Wide-field contact fundus photograph of an infant; 100° field of view (Phoenix ICON)
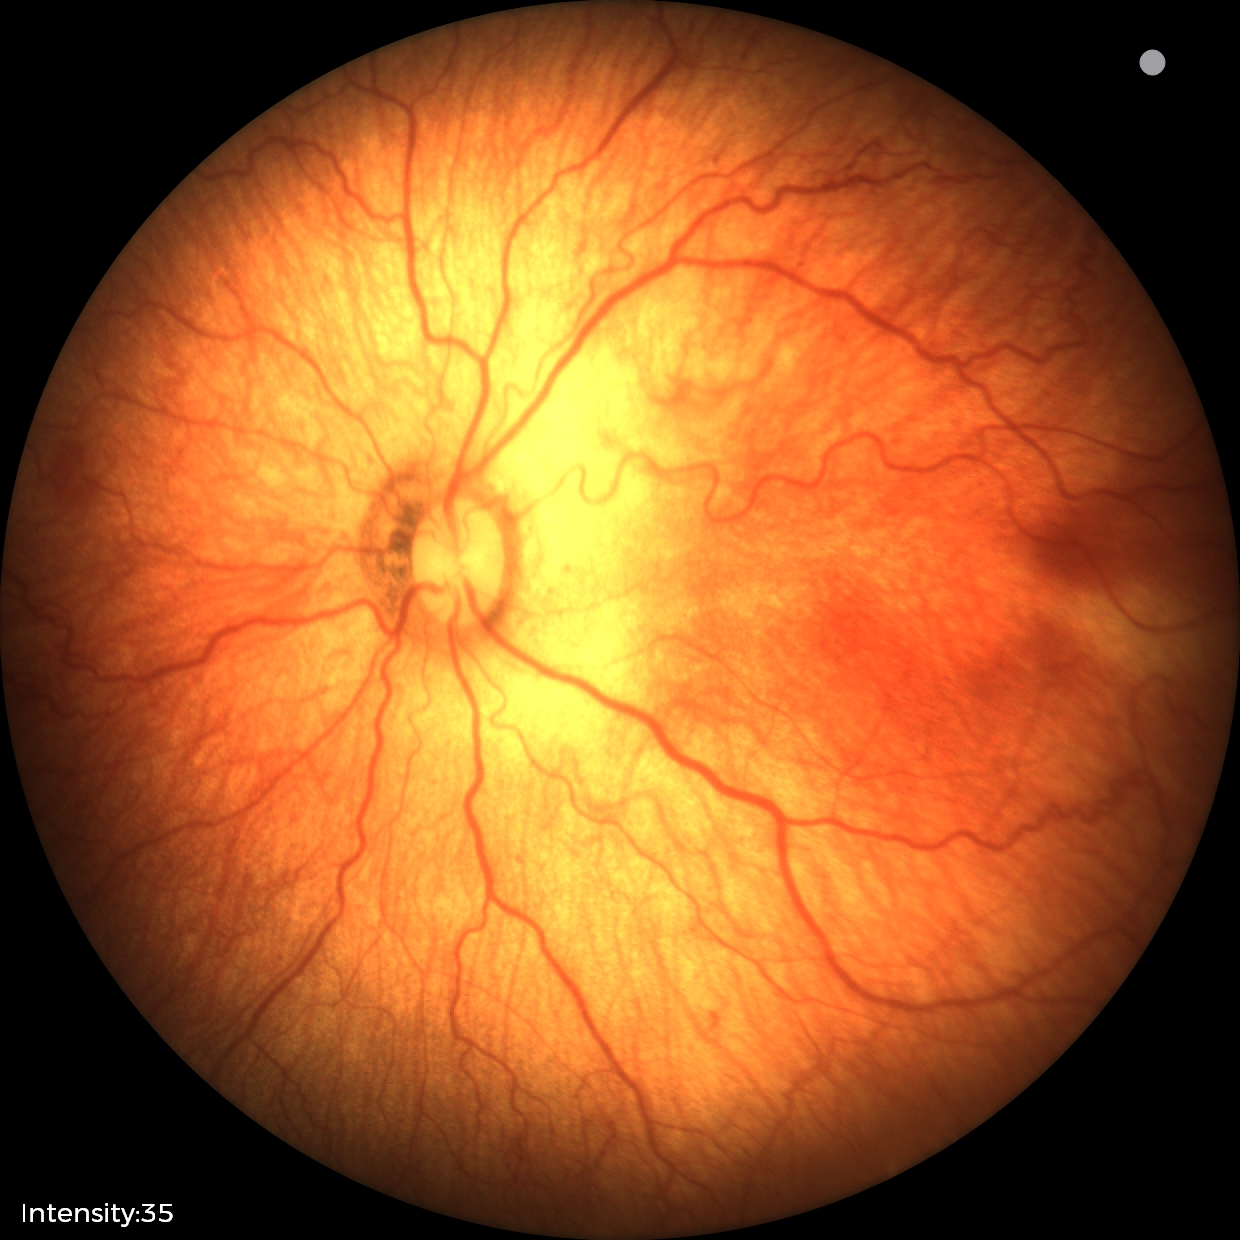 Screening series with retinopathy of prematurity stage 1. Plus disease present.